Image size 848x848; without pupil dilation — 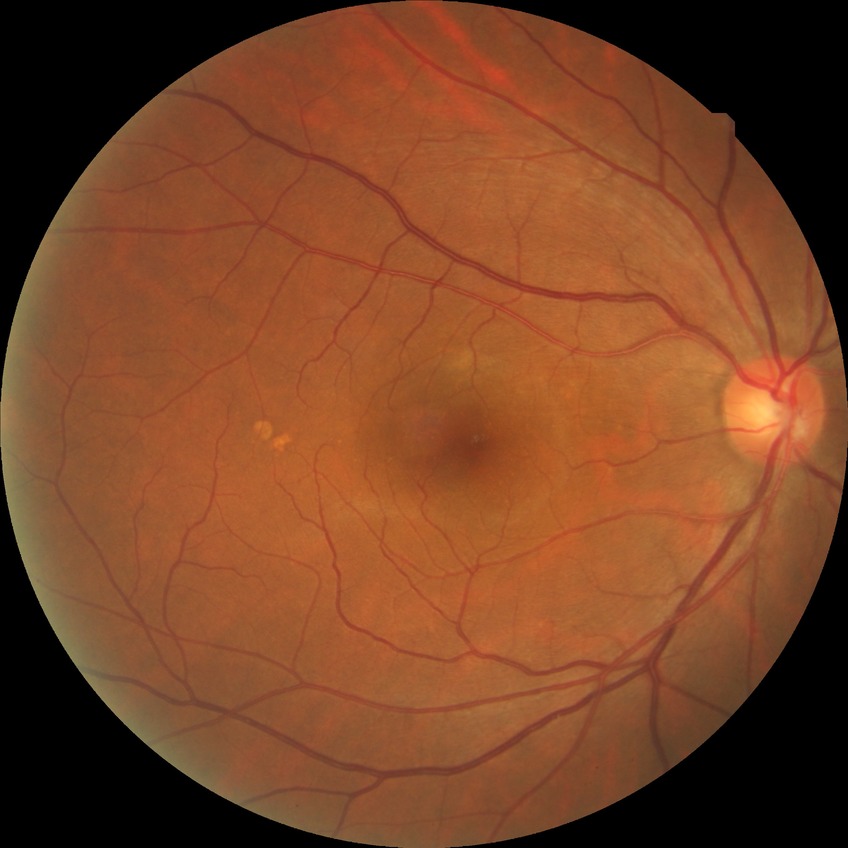 {"davis_grade": "no diabetic retinopathy (NDR)"}